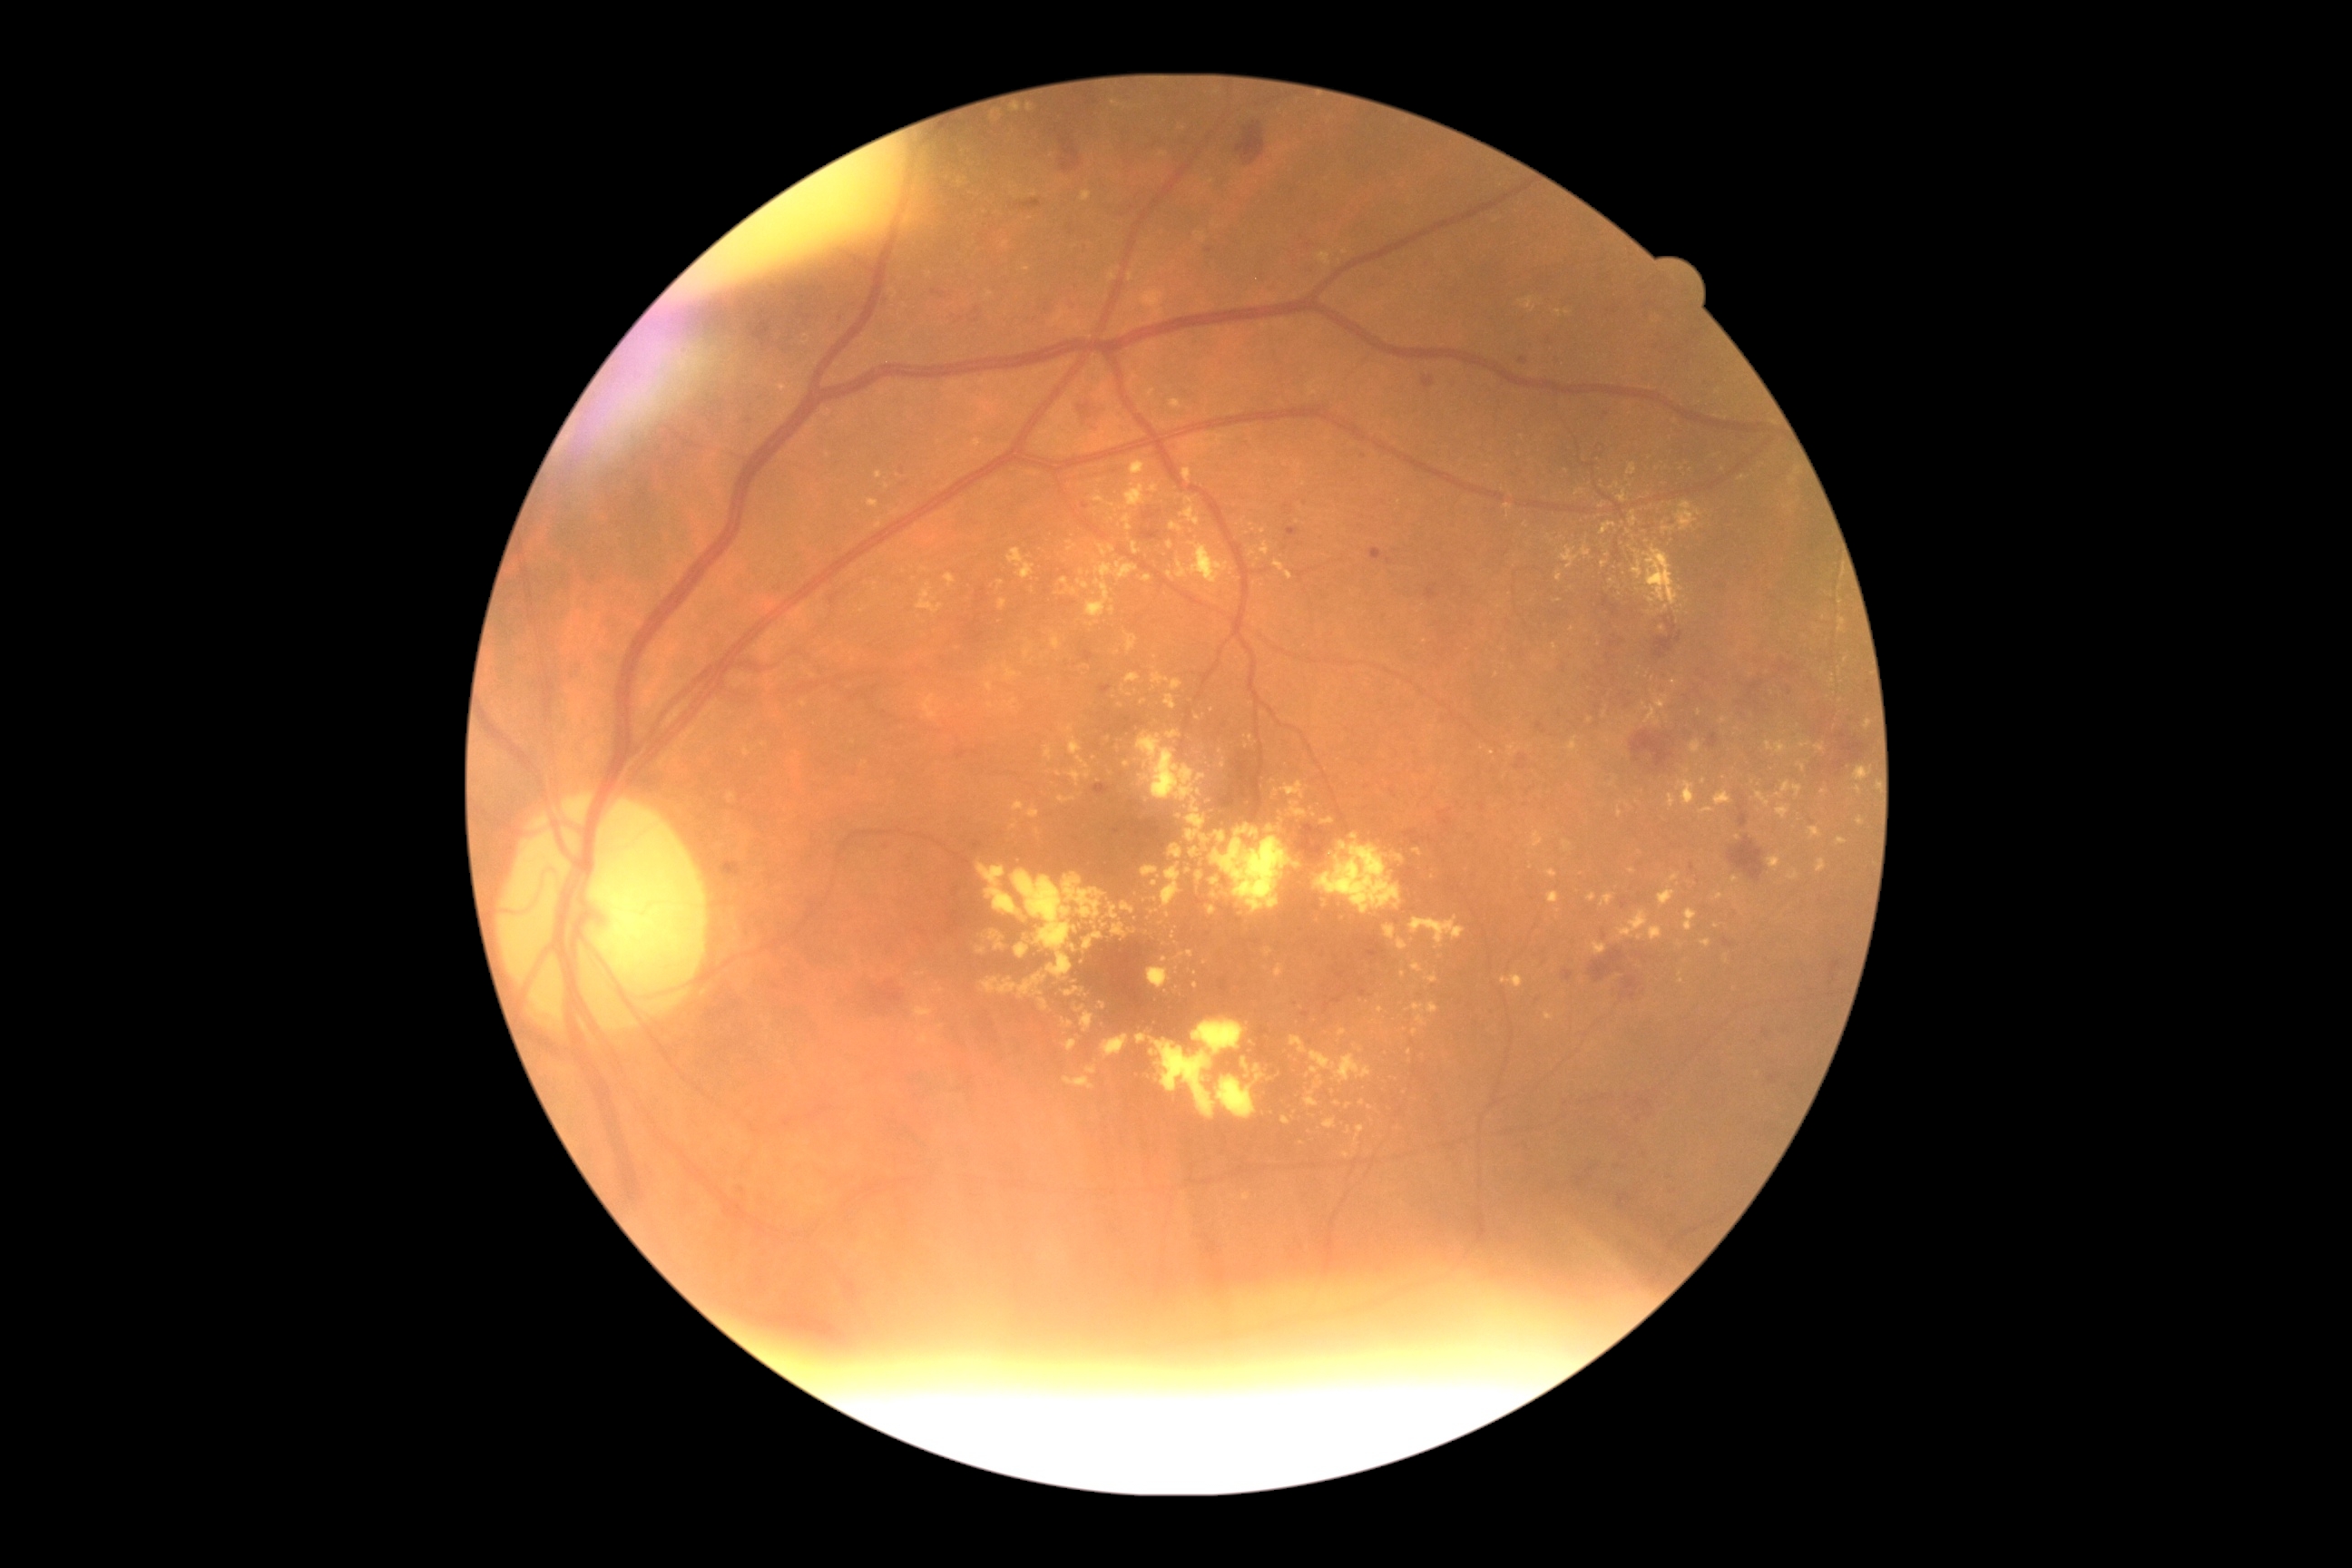 Diabetic retinopathy (DR) is 2
Representative lesions:
hard exudates (EXs) (subset) = <bbox>1028, 471, 1037, 476</bbox> | <bbox>1658, 890, 1676, 906</bbox> | <bbox>1324, 1119, 1337, 1130</bbox> | <bbox>1146, 968, 1171, 990</bbox> | <bbox>1810, 827, 1823, 839</bbox> | <bbox>1250, 1037, 1260, 1048</bbox> | <bbox>1195, 233, 1206, 242</bbox> | <bbox>986, 291, 995, 299</bbox> | <bbox>1769, 856, 1781, 872</bbox> | <bbox>1217, 1075, 1257, 1119</bbox> | <bbox>1148, 389, 1157, 398</bbox>
Small EXs near pt(1257, 1069) | pt(1060, 775) | pt(1558, 911) | pt(879, 476) | pt(764, 745) | pt(1618, 485) | pt(1155, 899) | pt(1613, 784)